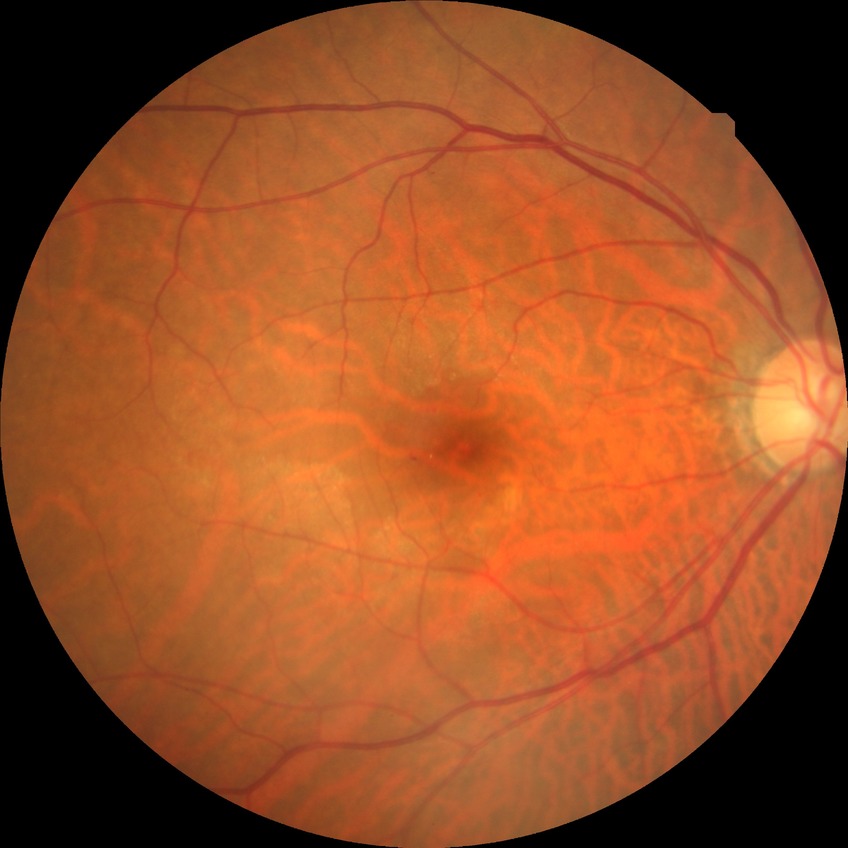
diabetic retinopathy (DR)@simple diabetic retinopathy (SDR).